Portable fundus camera image
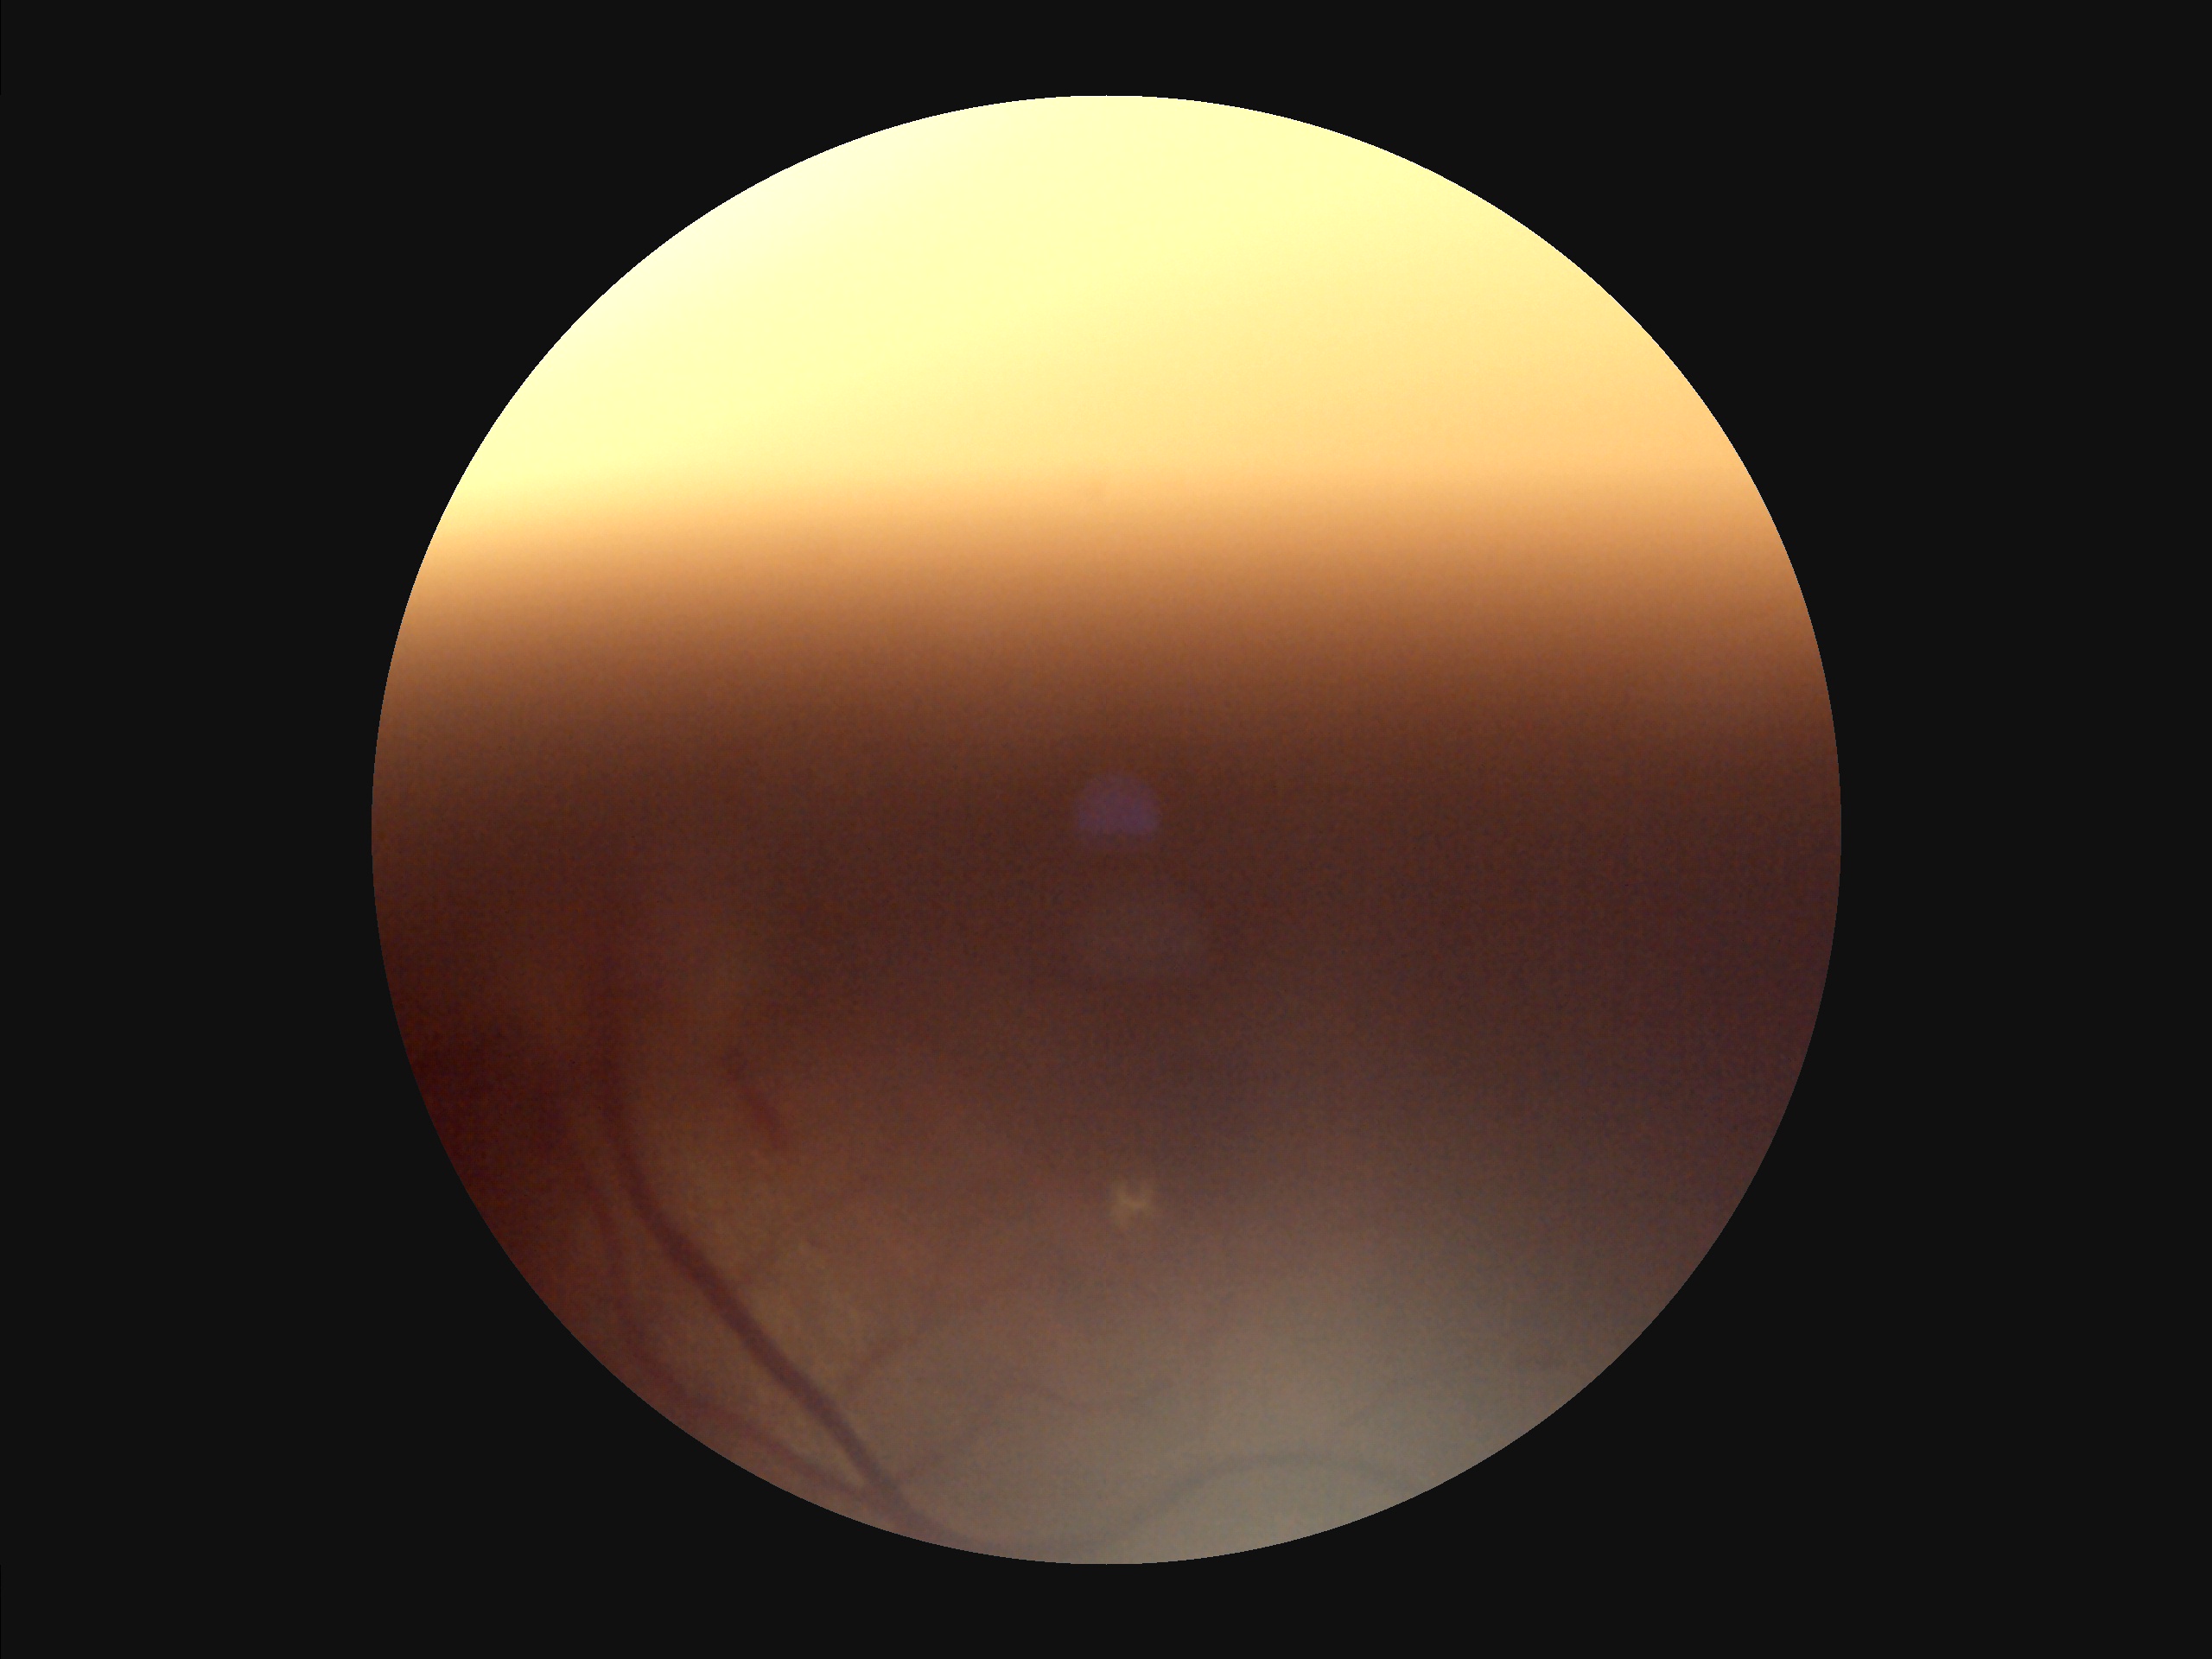

Sharpness: noticeable blur in the optic disc, vessels, or background; Contrast: narrow intensity range, structures hard to distinguish; Overall image quality: poor and difficult to use diagnostically; Illumination/color: uneven illumination or color cast.